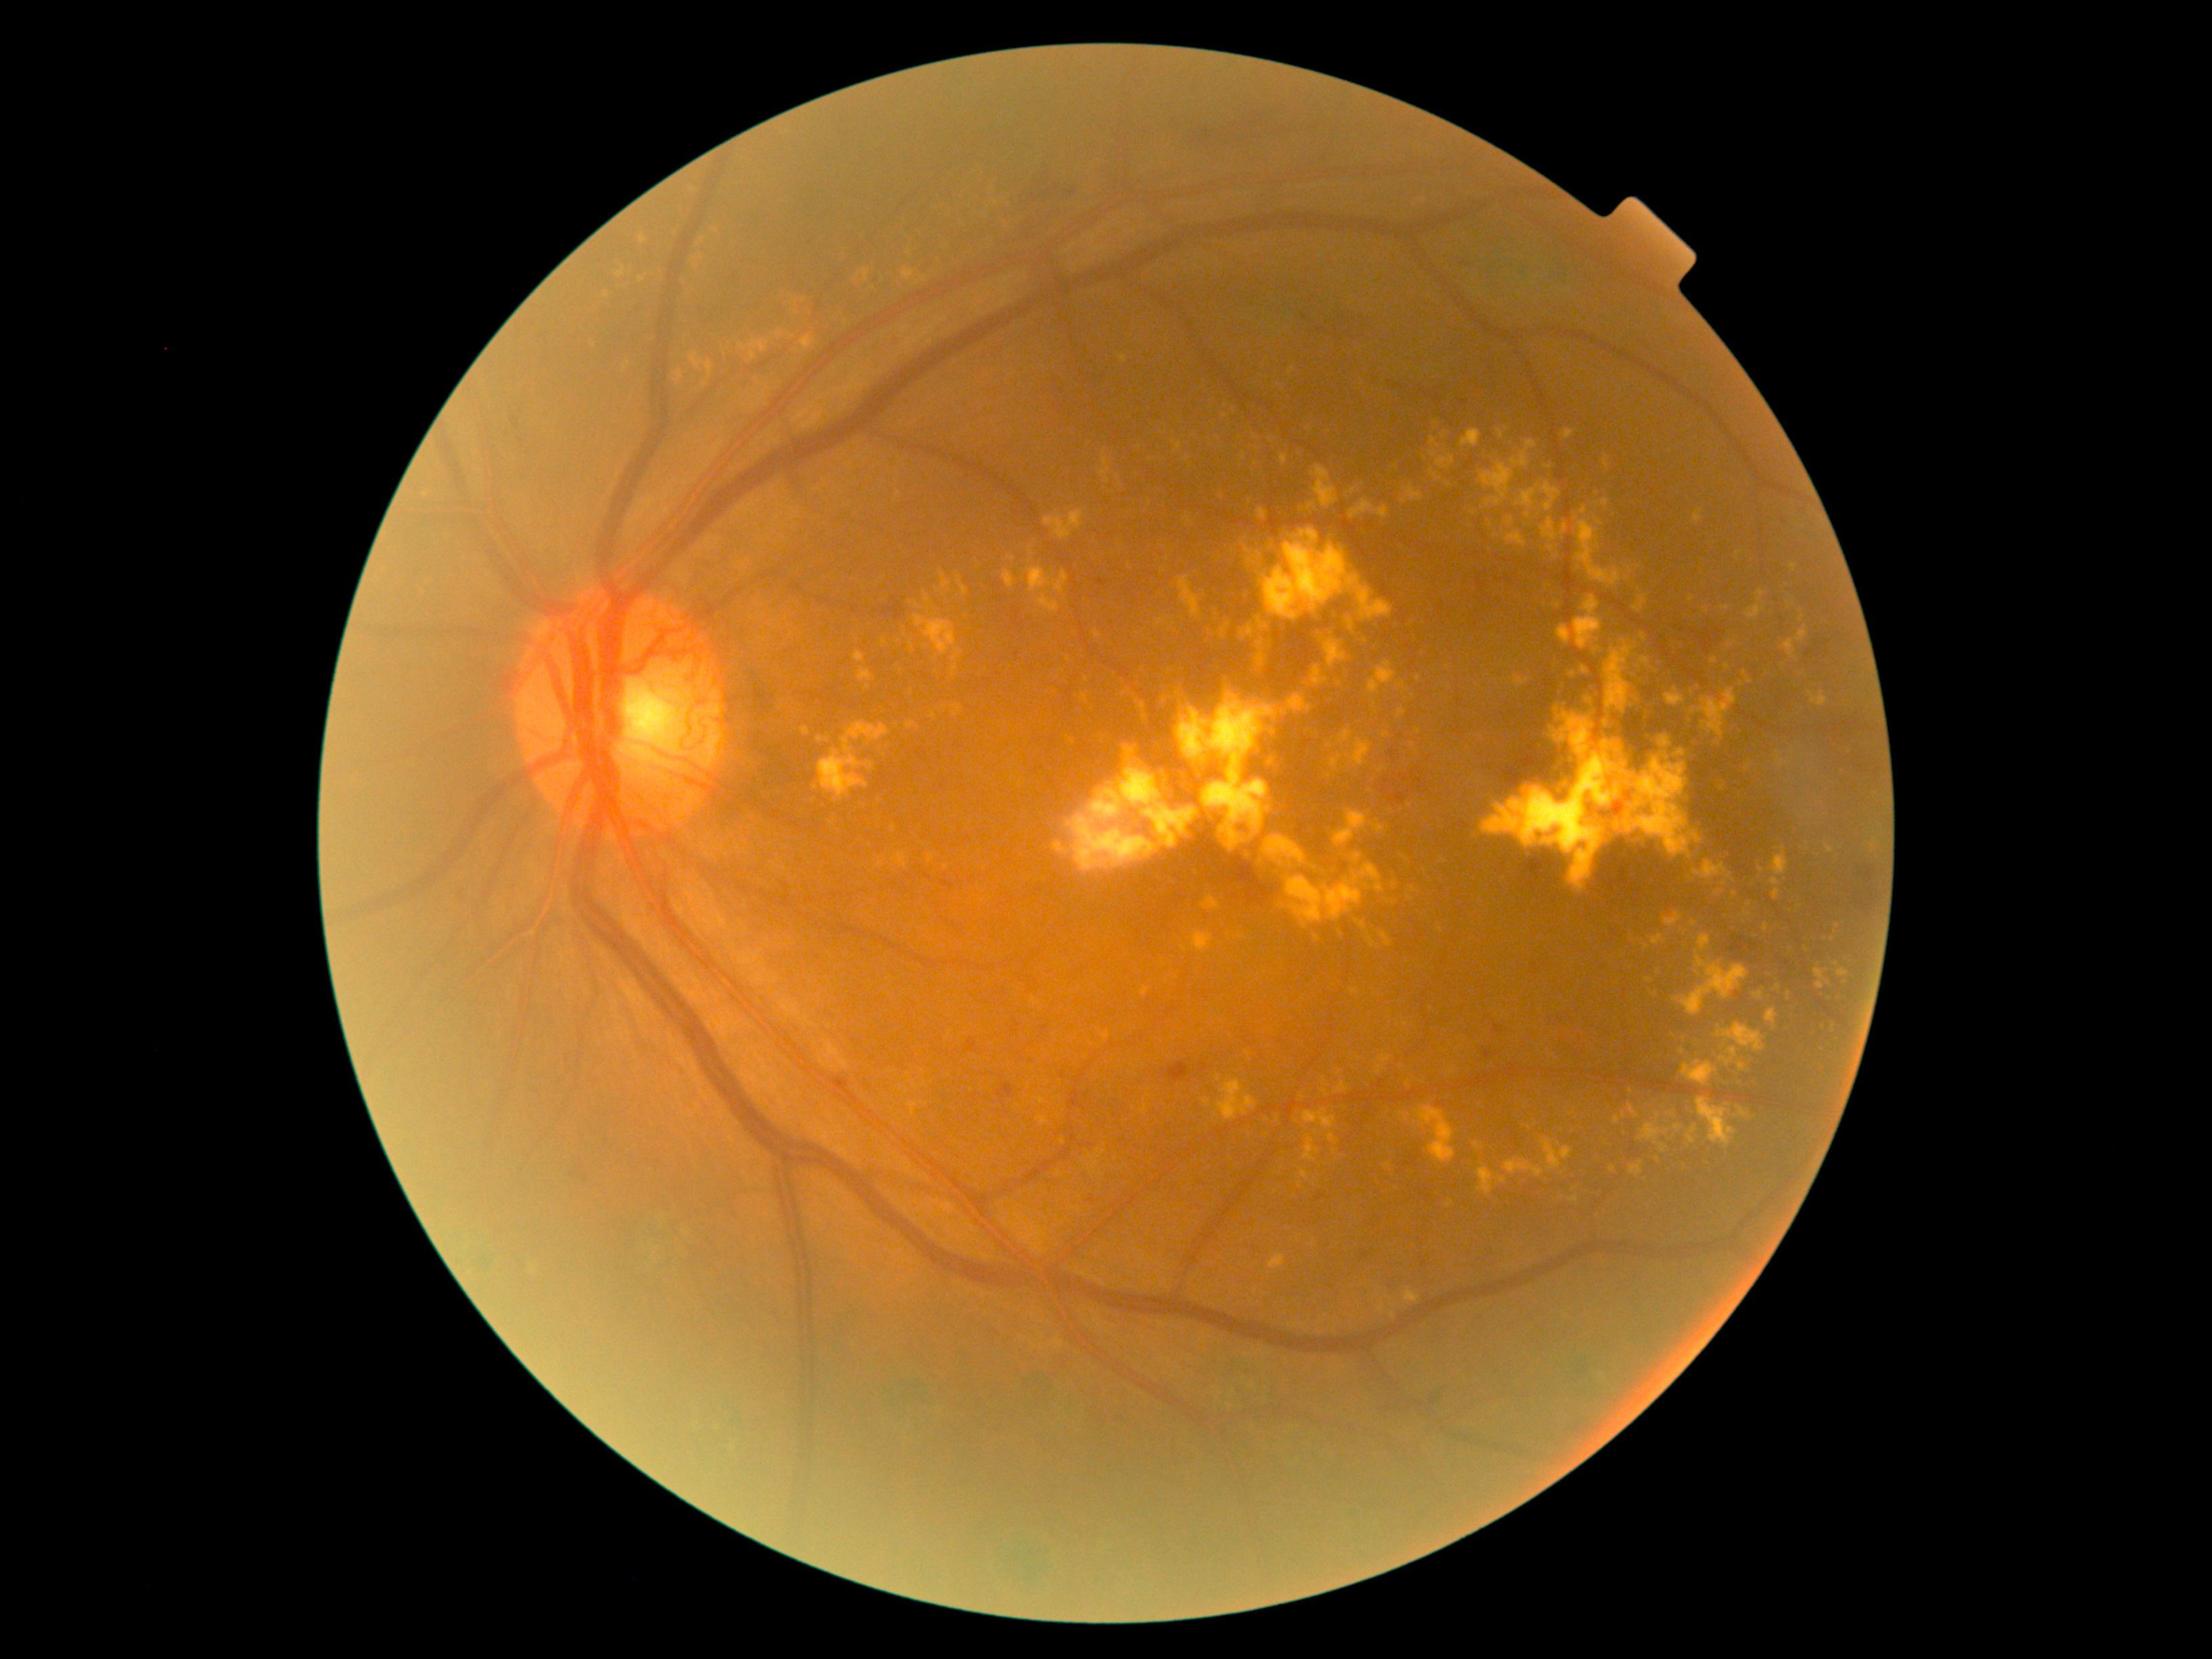

{"partial": true, "dr_grade": 4, "dr_grade_name": "PDR", "lesions": {"ex": [[1664, 913, 1684, 928], [1103, 1032, 1109, 1042], [1311, 467, 1338, 509], [1174, 689, 1185, 704], [1288, 693, 1311, 715], [1136, 699, 1147, 719], [853, 653, 864, 663], [1623, 791, 1631, 796], [818, 723, 891, 800], [1555, 1170, 1563, 1177], [1581, 666, 1589, 676], [1307, 502, 1317, 512]], "ex_small": [[1388, 1167], [1209, 633], [1398, 623], [1313, 1246], [880, 865], [1086, 680], [1441, 930], [1595, 1214]]}}